2361 x 1568 pixels · captured after pupil dilation · FOV: 50 degrees · retinal fundus photograph · camera: Kowa VX-10α.
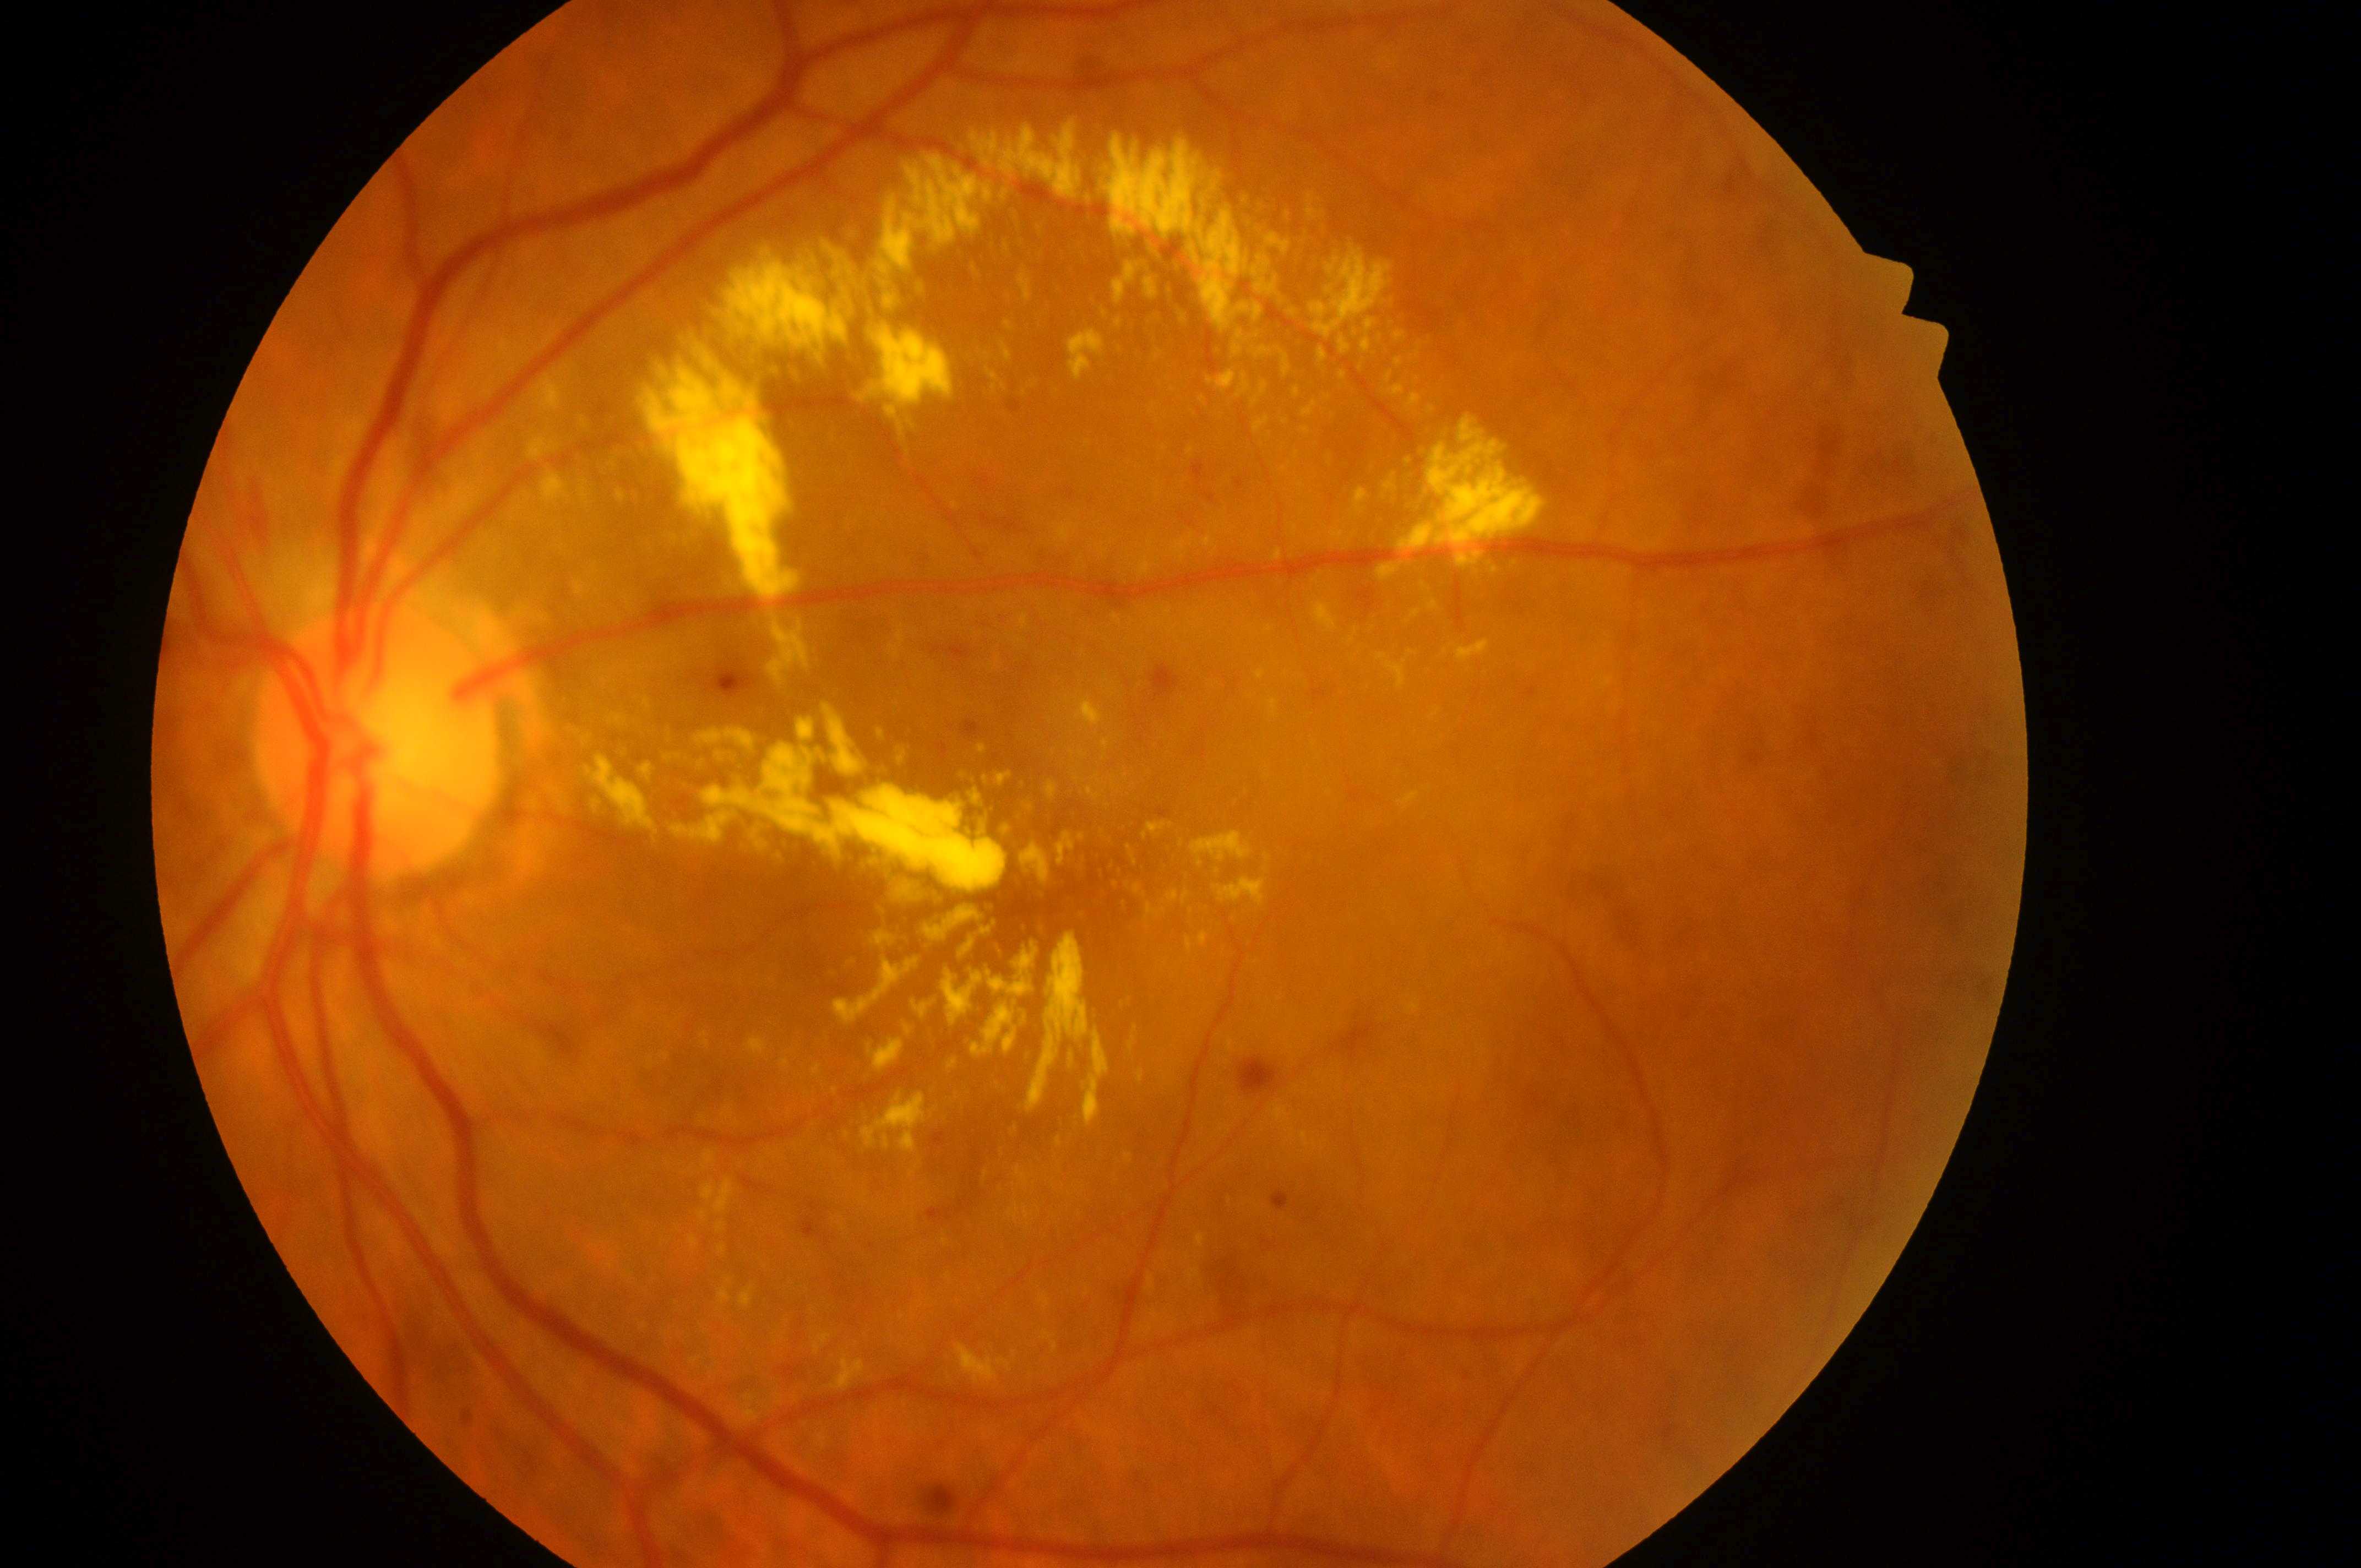 DR stage: grade 2 (moderate NPDR); laterality: oculus sinister; disc center: (375, 754); fovea center: (1064, 886); DME grade: 2 (high risk).